CFP:
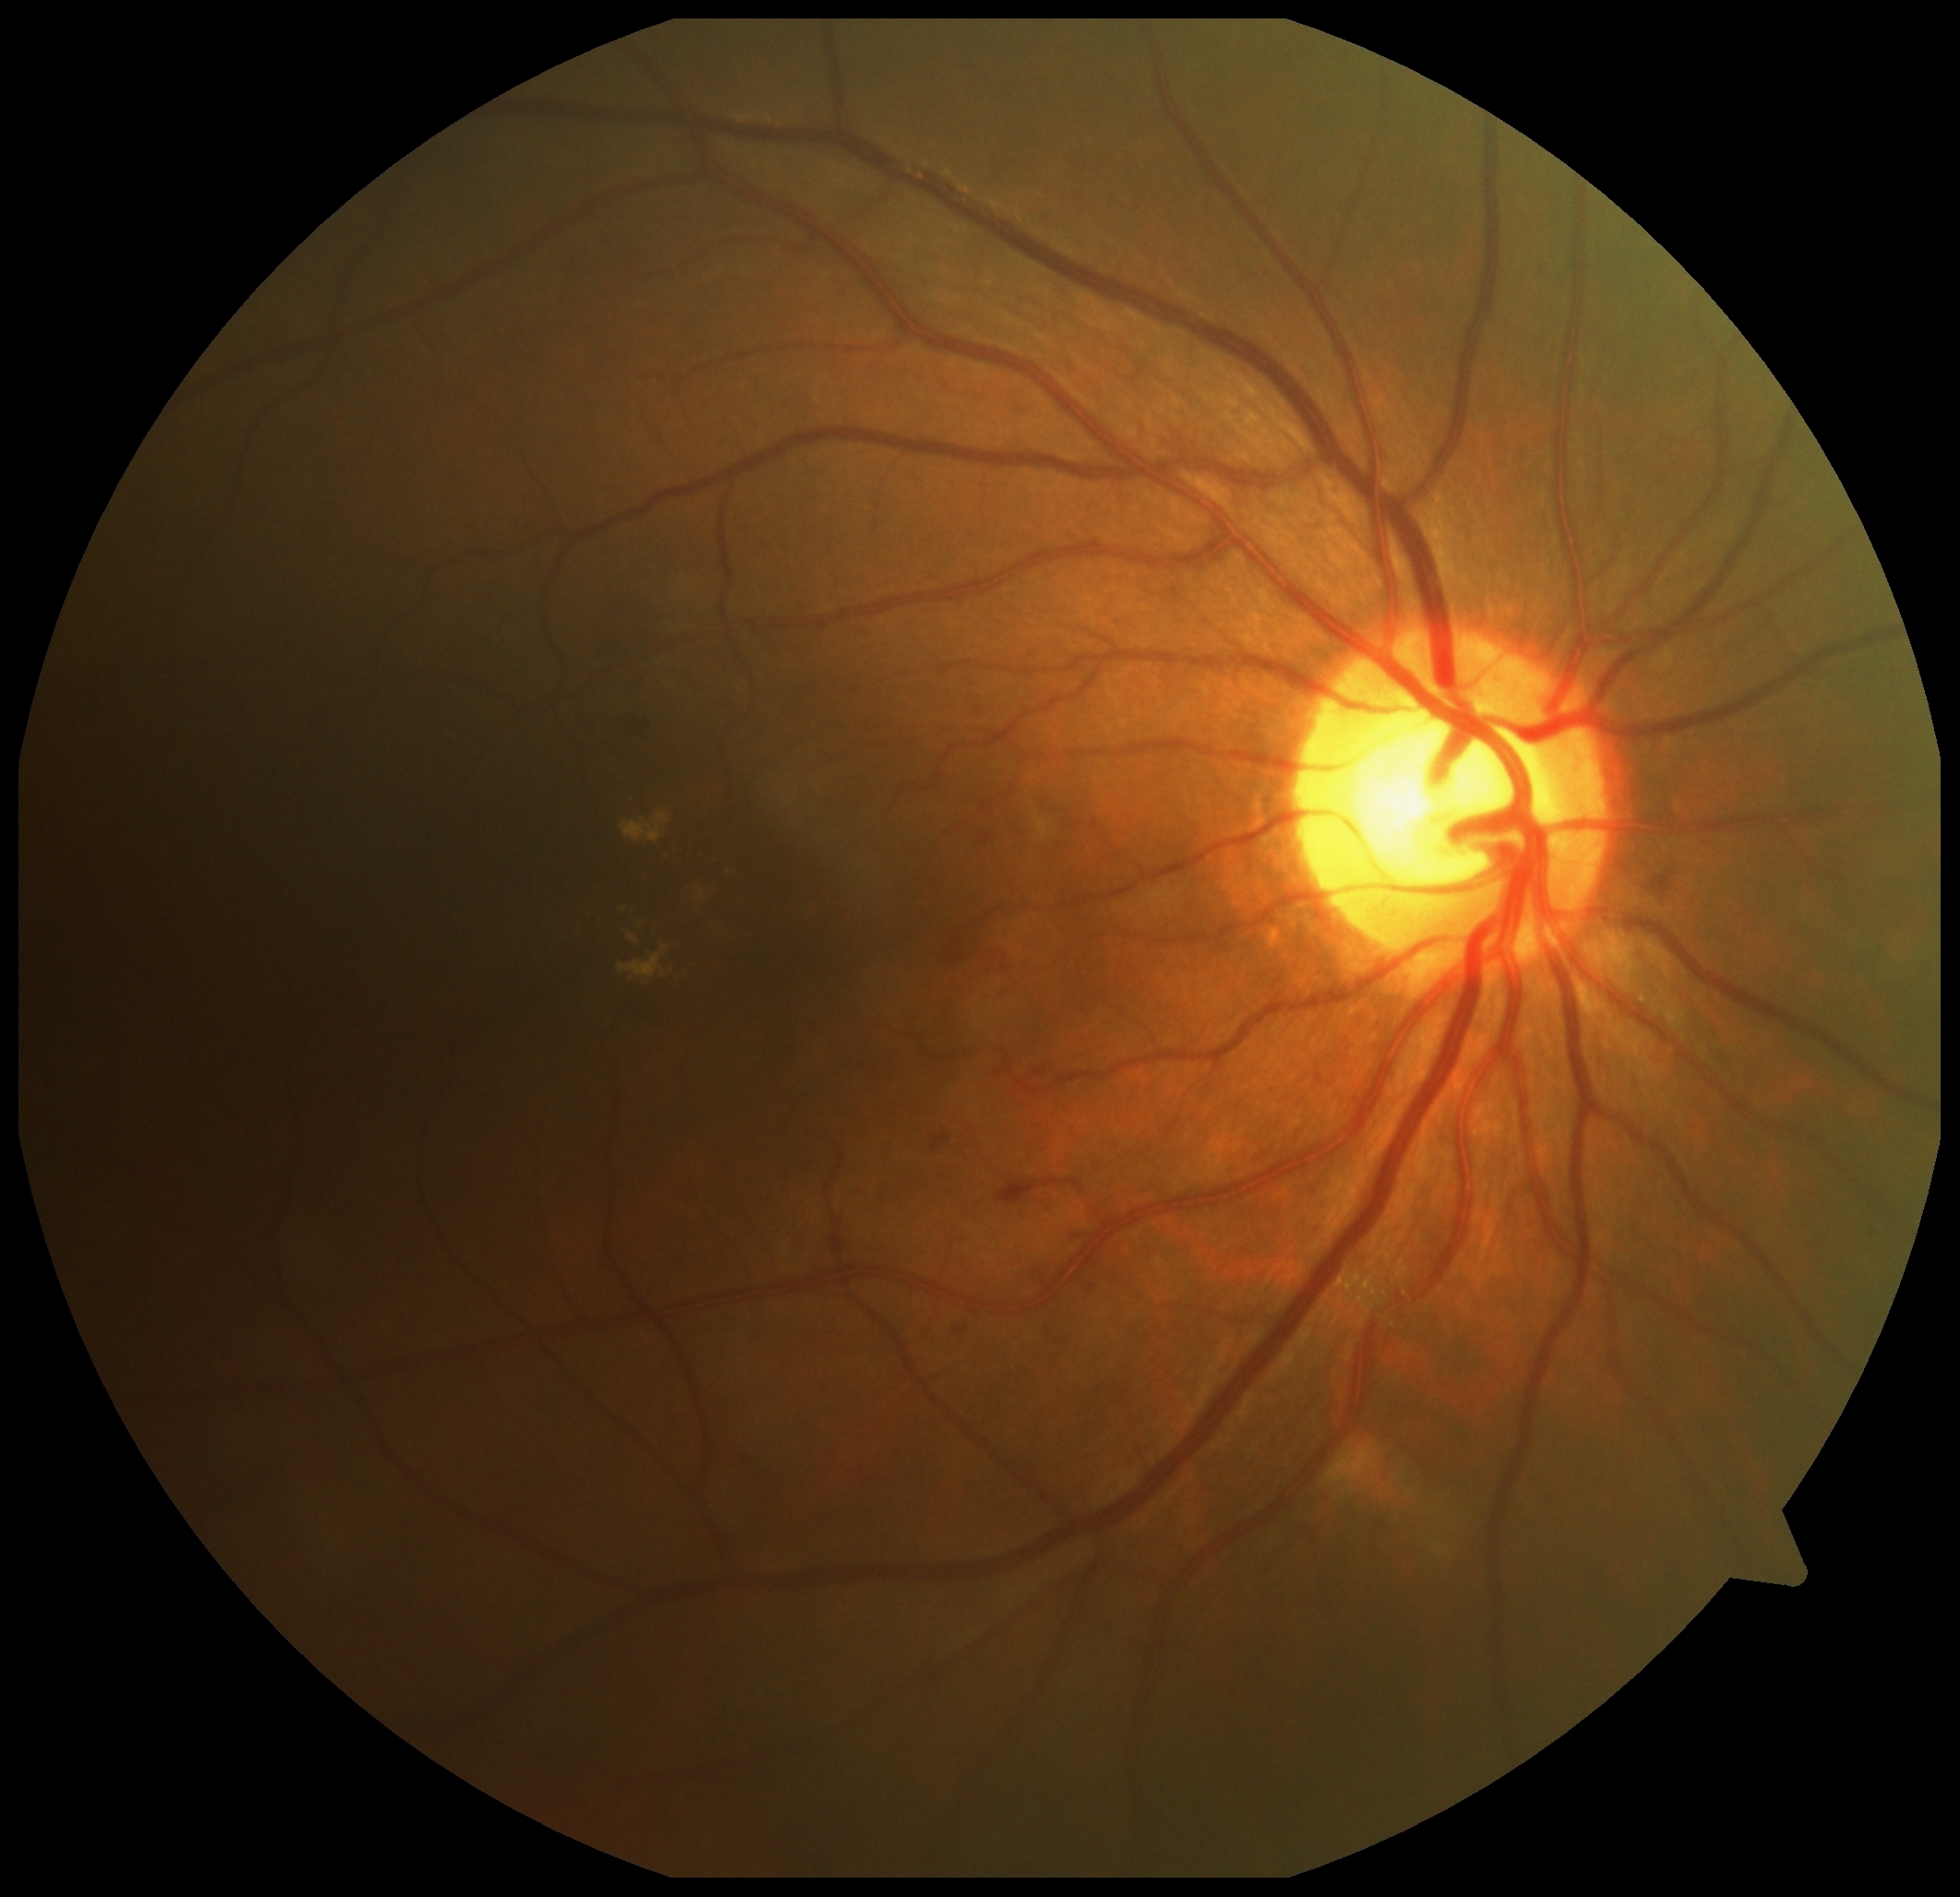 Diabetic retinopathy (DR): 2
soft exudates (SEs): absent
hemorrhages (HEs): x1=581 y1=593 x2=674 y2=700 | x1=838 y1=1125 x2=855 y2=1144 | x1=1317 y1=1074 x2=1322 y2=1082 | x1=949 y1=1229 x2=969 y2=1247 | x1=1029 y1=1260 x2=1063 y2=1287 | x1=983 y1=834 x2=996 y2=845 | x1=809 y1=1016 x2=822 y2=1039 | x1=612 y1=708 x2=655 y2=746 | x1=1166 y1=1119 x2=1182 y2=1135 | x1=949 y1=1320 x2=969 y2=1338 | x1=644 y1=1514 x2=661 y2=1530 | x1=1076 y1=1280 x2=1103 y2=1298 | x1=1668 y1=905 x2=1677 y2=909 | x1=1635 y1=860 x2=1701 y2=903 | x1=998 y1=1178 x2=1084 y2=1206 | x1=947 y1=913 x2=1020 y2=981 | x1=1703 y1=934 x2=1714 y2=947 | x1=932 y1=1135 x2=952 y2=1153 | x1=1331 y1=483 x2=1340 y2=495
HEs (small, approximate centers) near (1077; 1238)
microaneurysms (MAs): absent
hard exudates (EXs): x1=615 y1=900 x2=702 y2=990 | x1=639 y1=873 x2=648 y2=883 | x1=619 y1=811 x2=747 y2=877 | x1=674 y1=877 x2=719 y2=916